DR severity per modified Davis staging · 848 by 848 pixels: 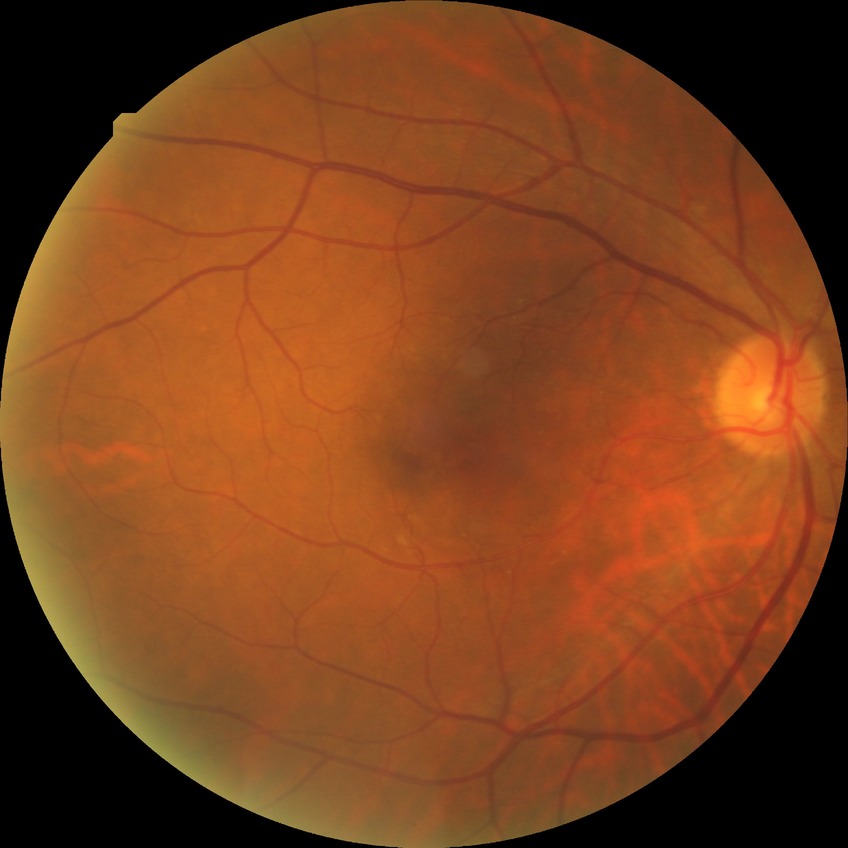

diabetic retinopathy stage: simple diabetic retinopathy.